45° field of view:
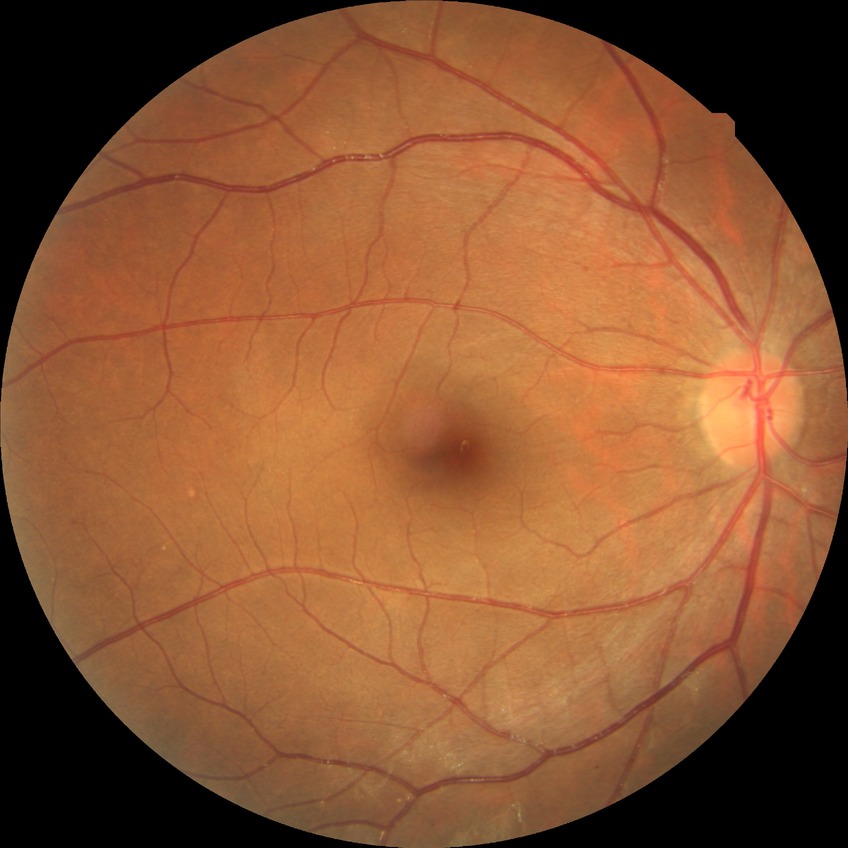 Diabetic retinopathy grade is no diabetic retinopathy.